Image size 2352x1568, FOV: 45 degrees — 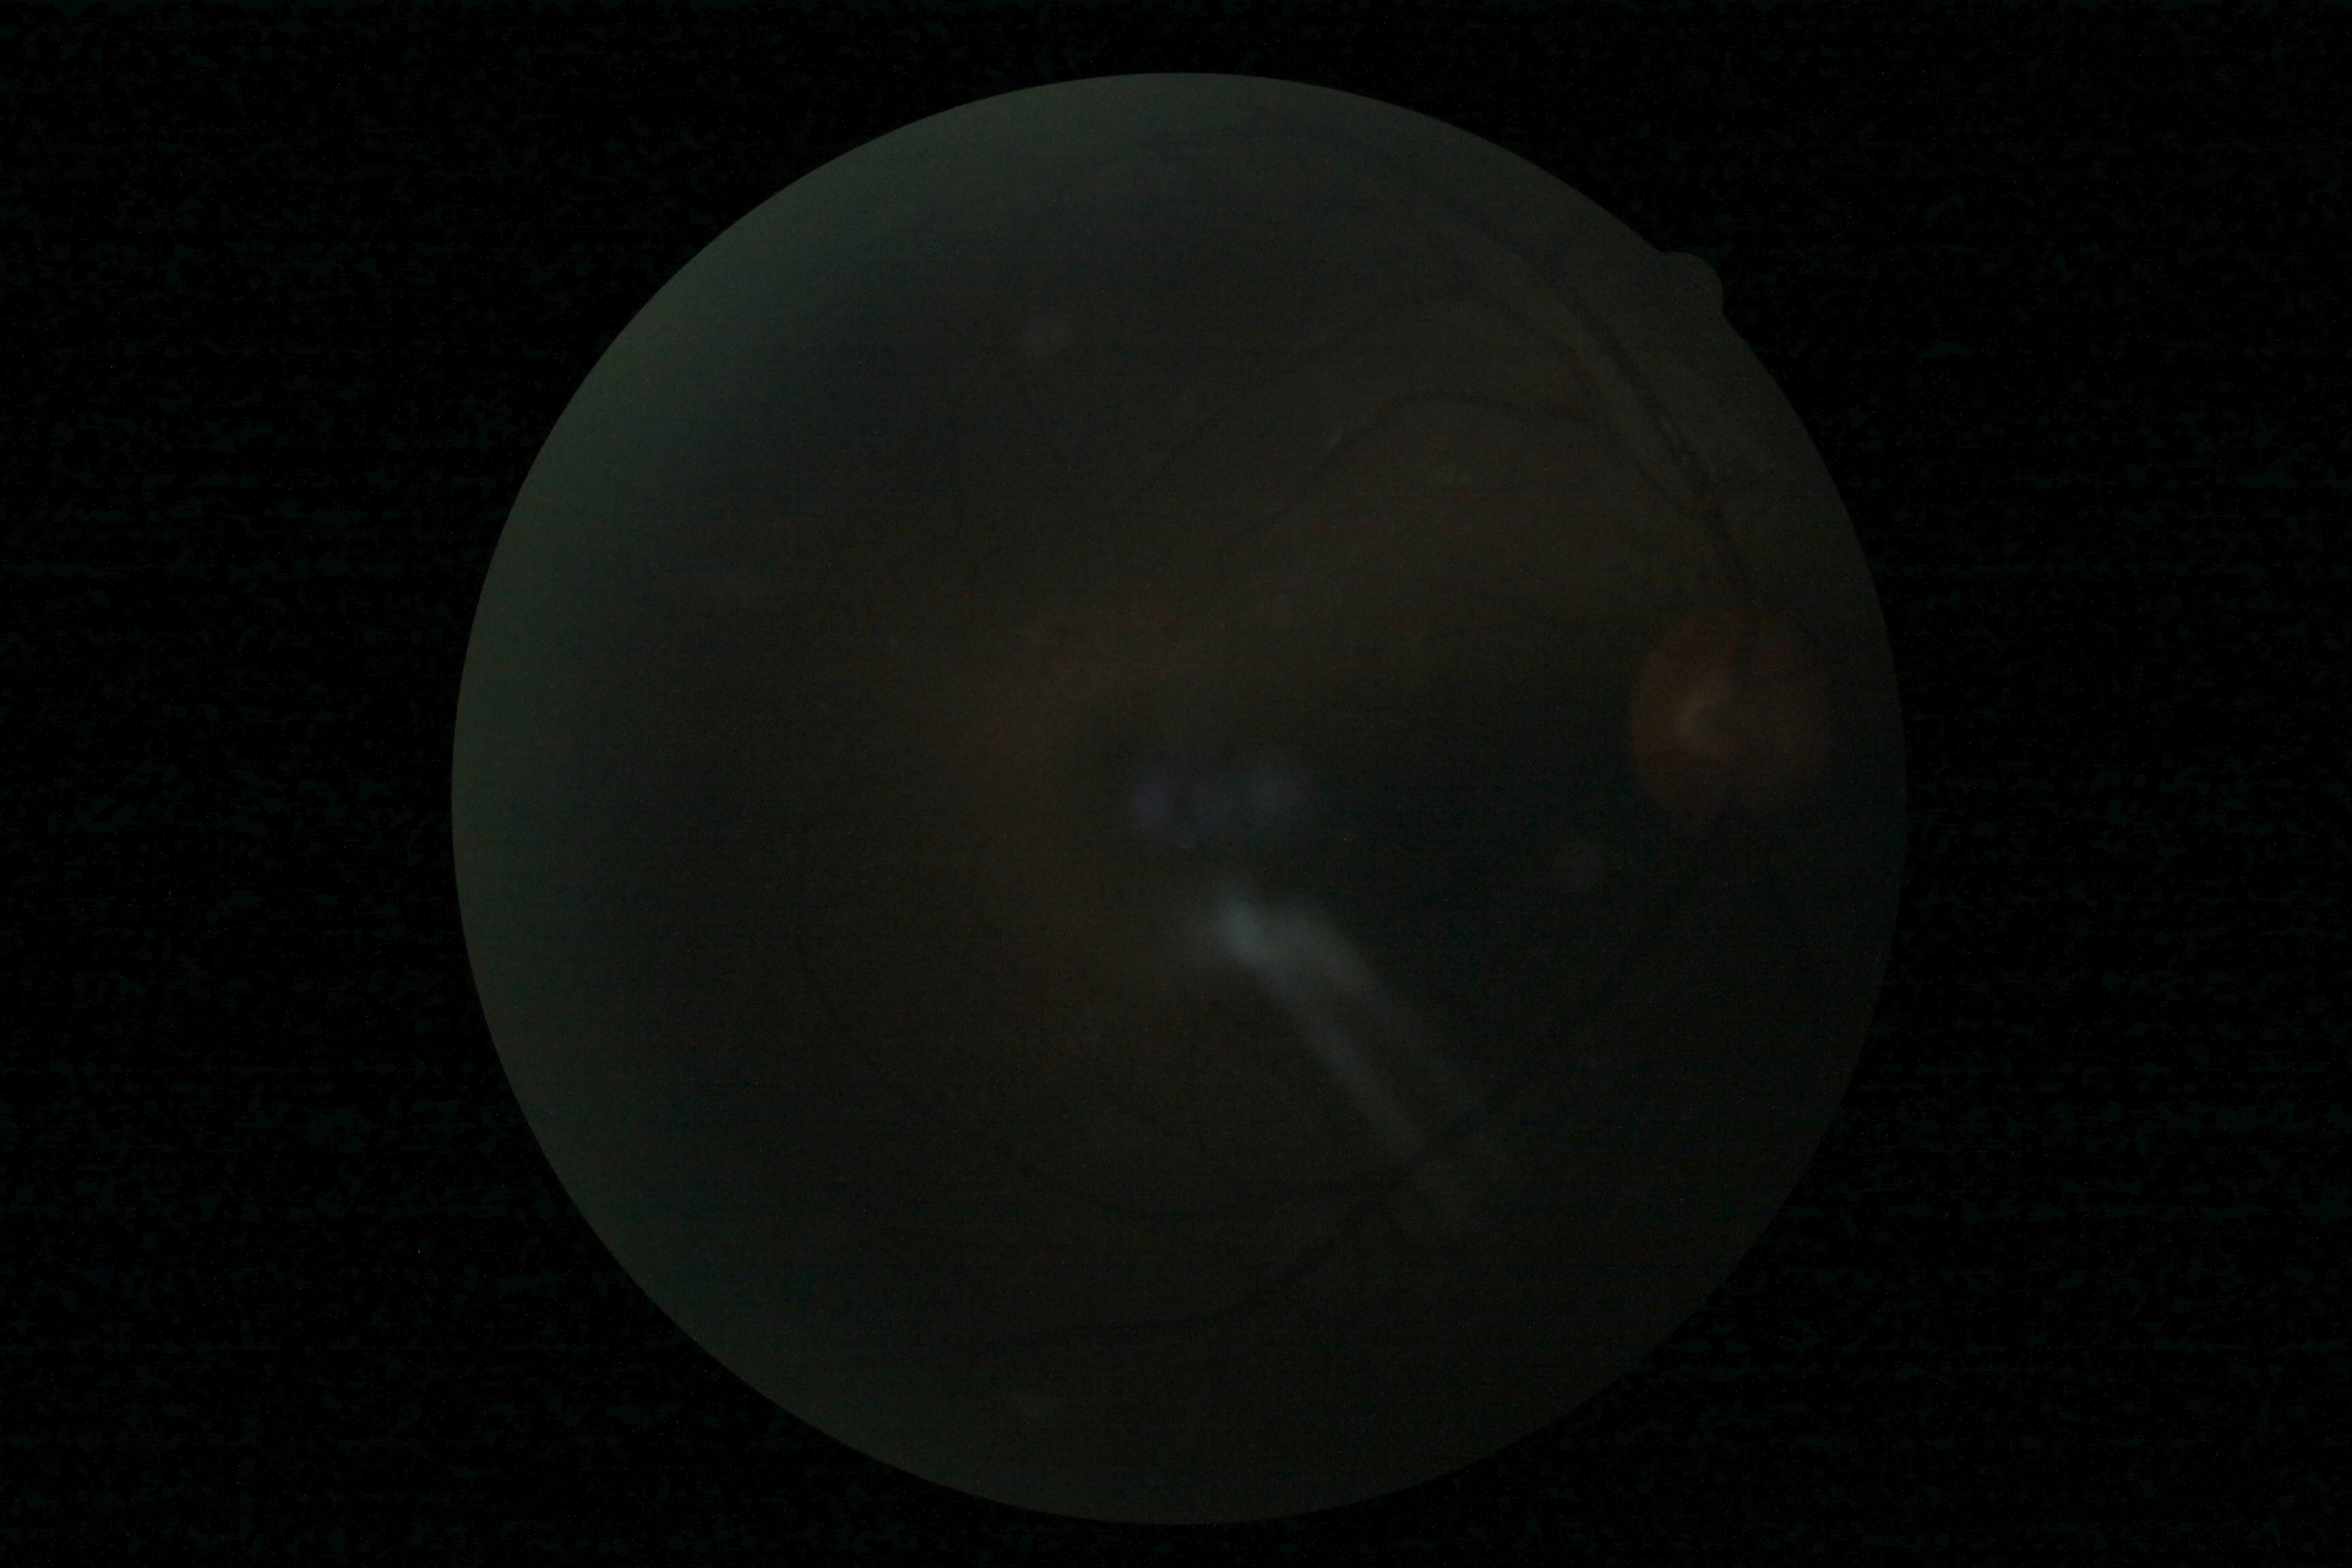

DR stage: ungradable.